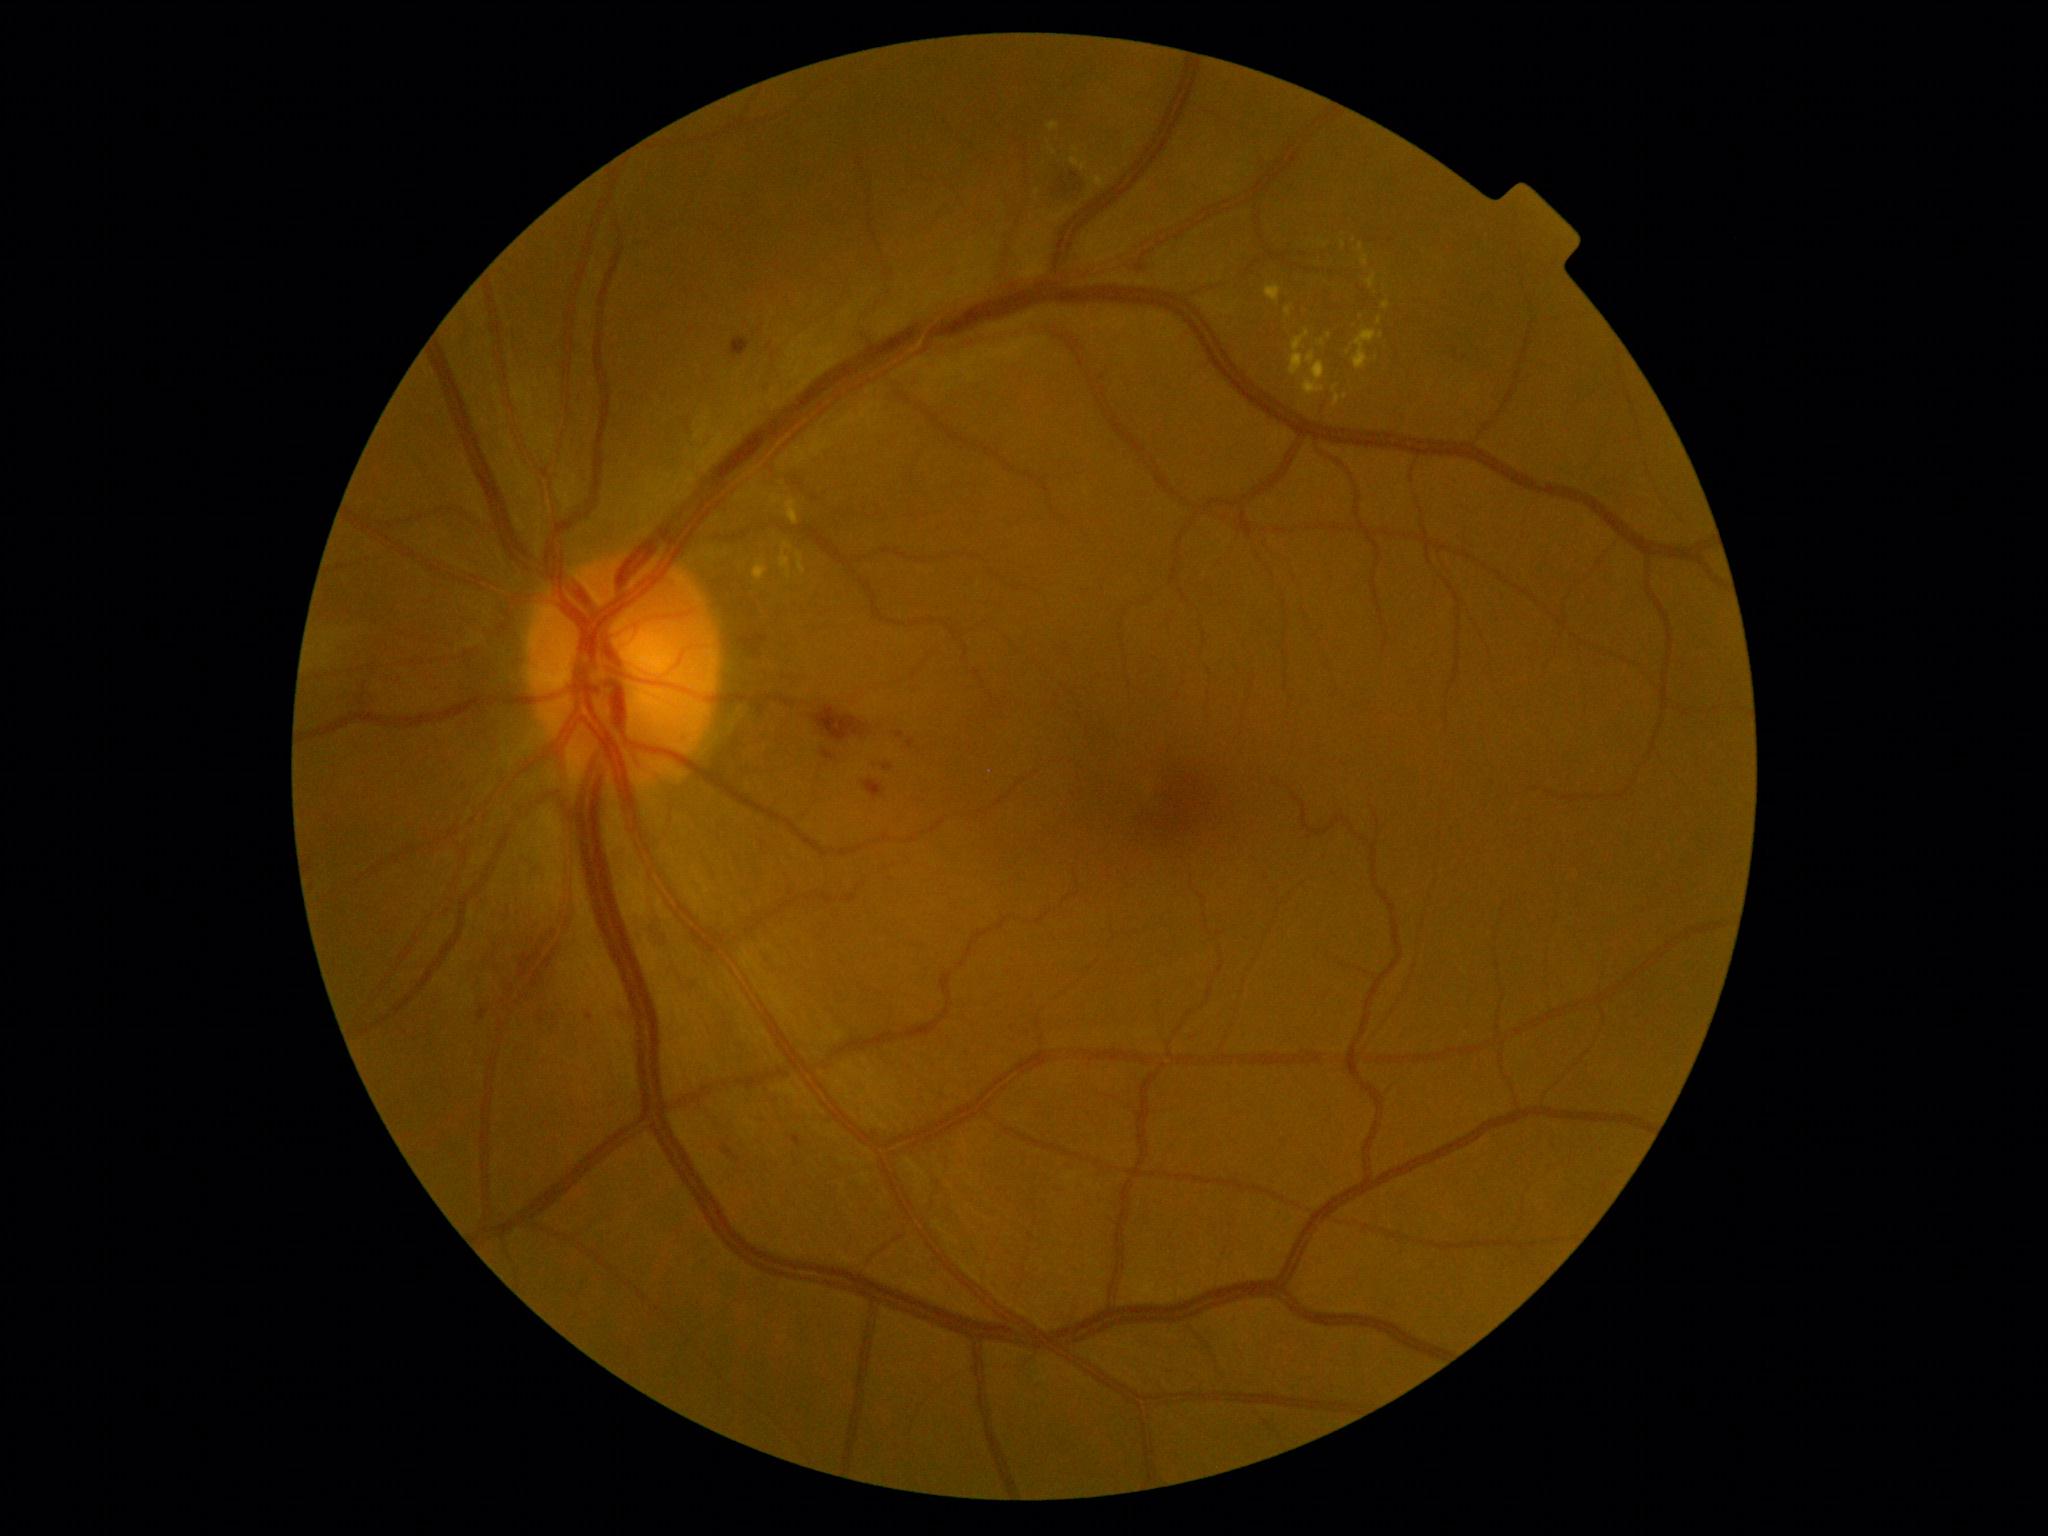
{"partial": true, "dr_grade": 2, "dr_grade_name": "moderate NPDR", "lesions": {"ex": [[1383, 302, 1390, 311], [786, 498, 799, 526], [1319, 339, 1324, 347], [1353, 331, 1383, 371], [1366, 275, 1376, 289], [797, 553, 806, 574], [1048, 123, 1059, 132], [1092, 176, 1105, 188]], "ex_small": [[1345, 397], [1361, 247], [1325, 246]]}}